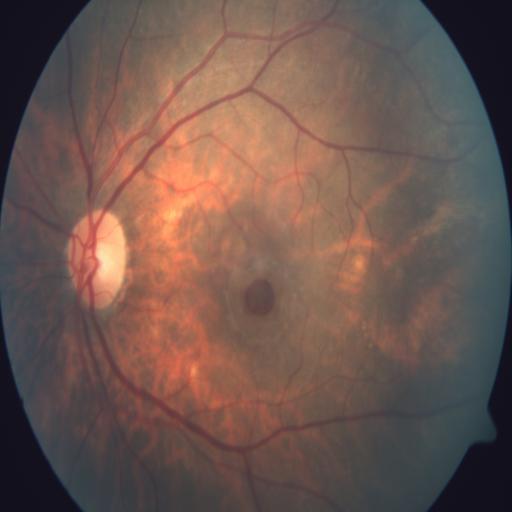

Pathology (3): macular hole | myopia | tessellation.